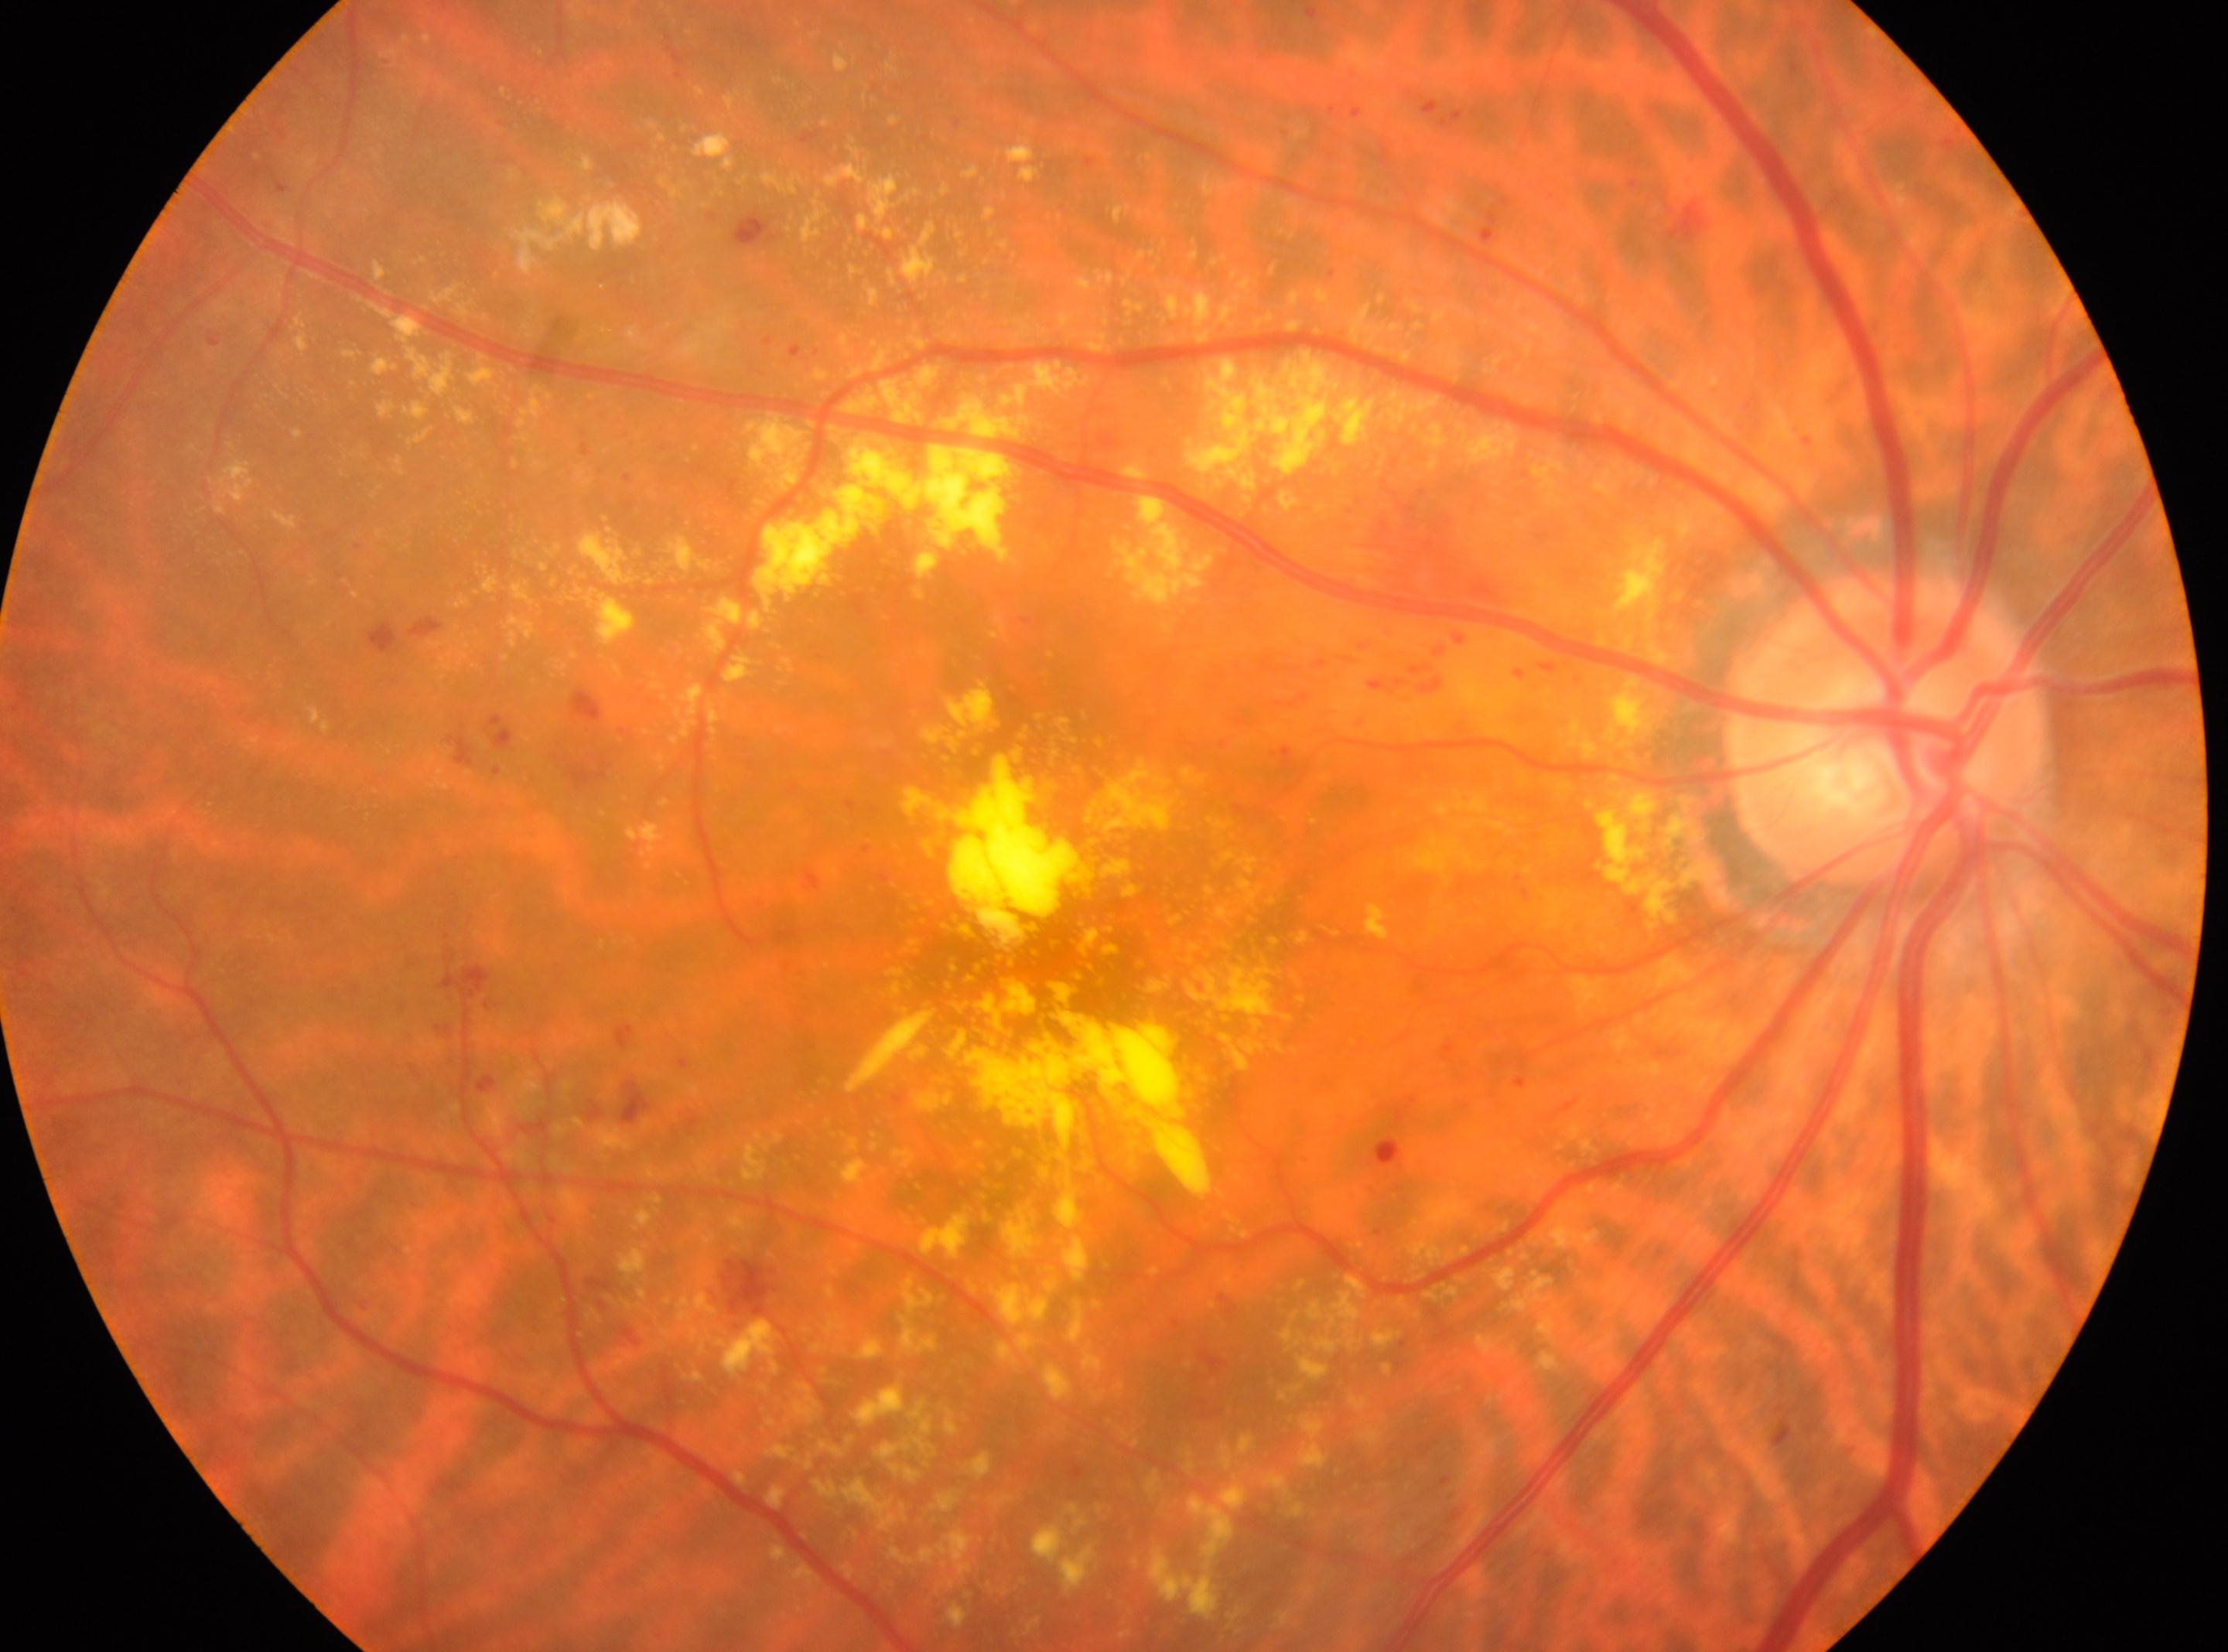
The image shows the right eye. Fovea centralis: 1106, 984. Retinopathy grade is moderate NPDR (2). Optic disc located at 1884, 730.